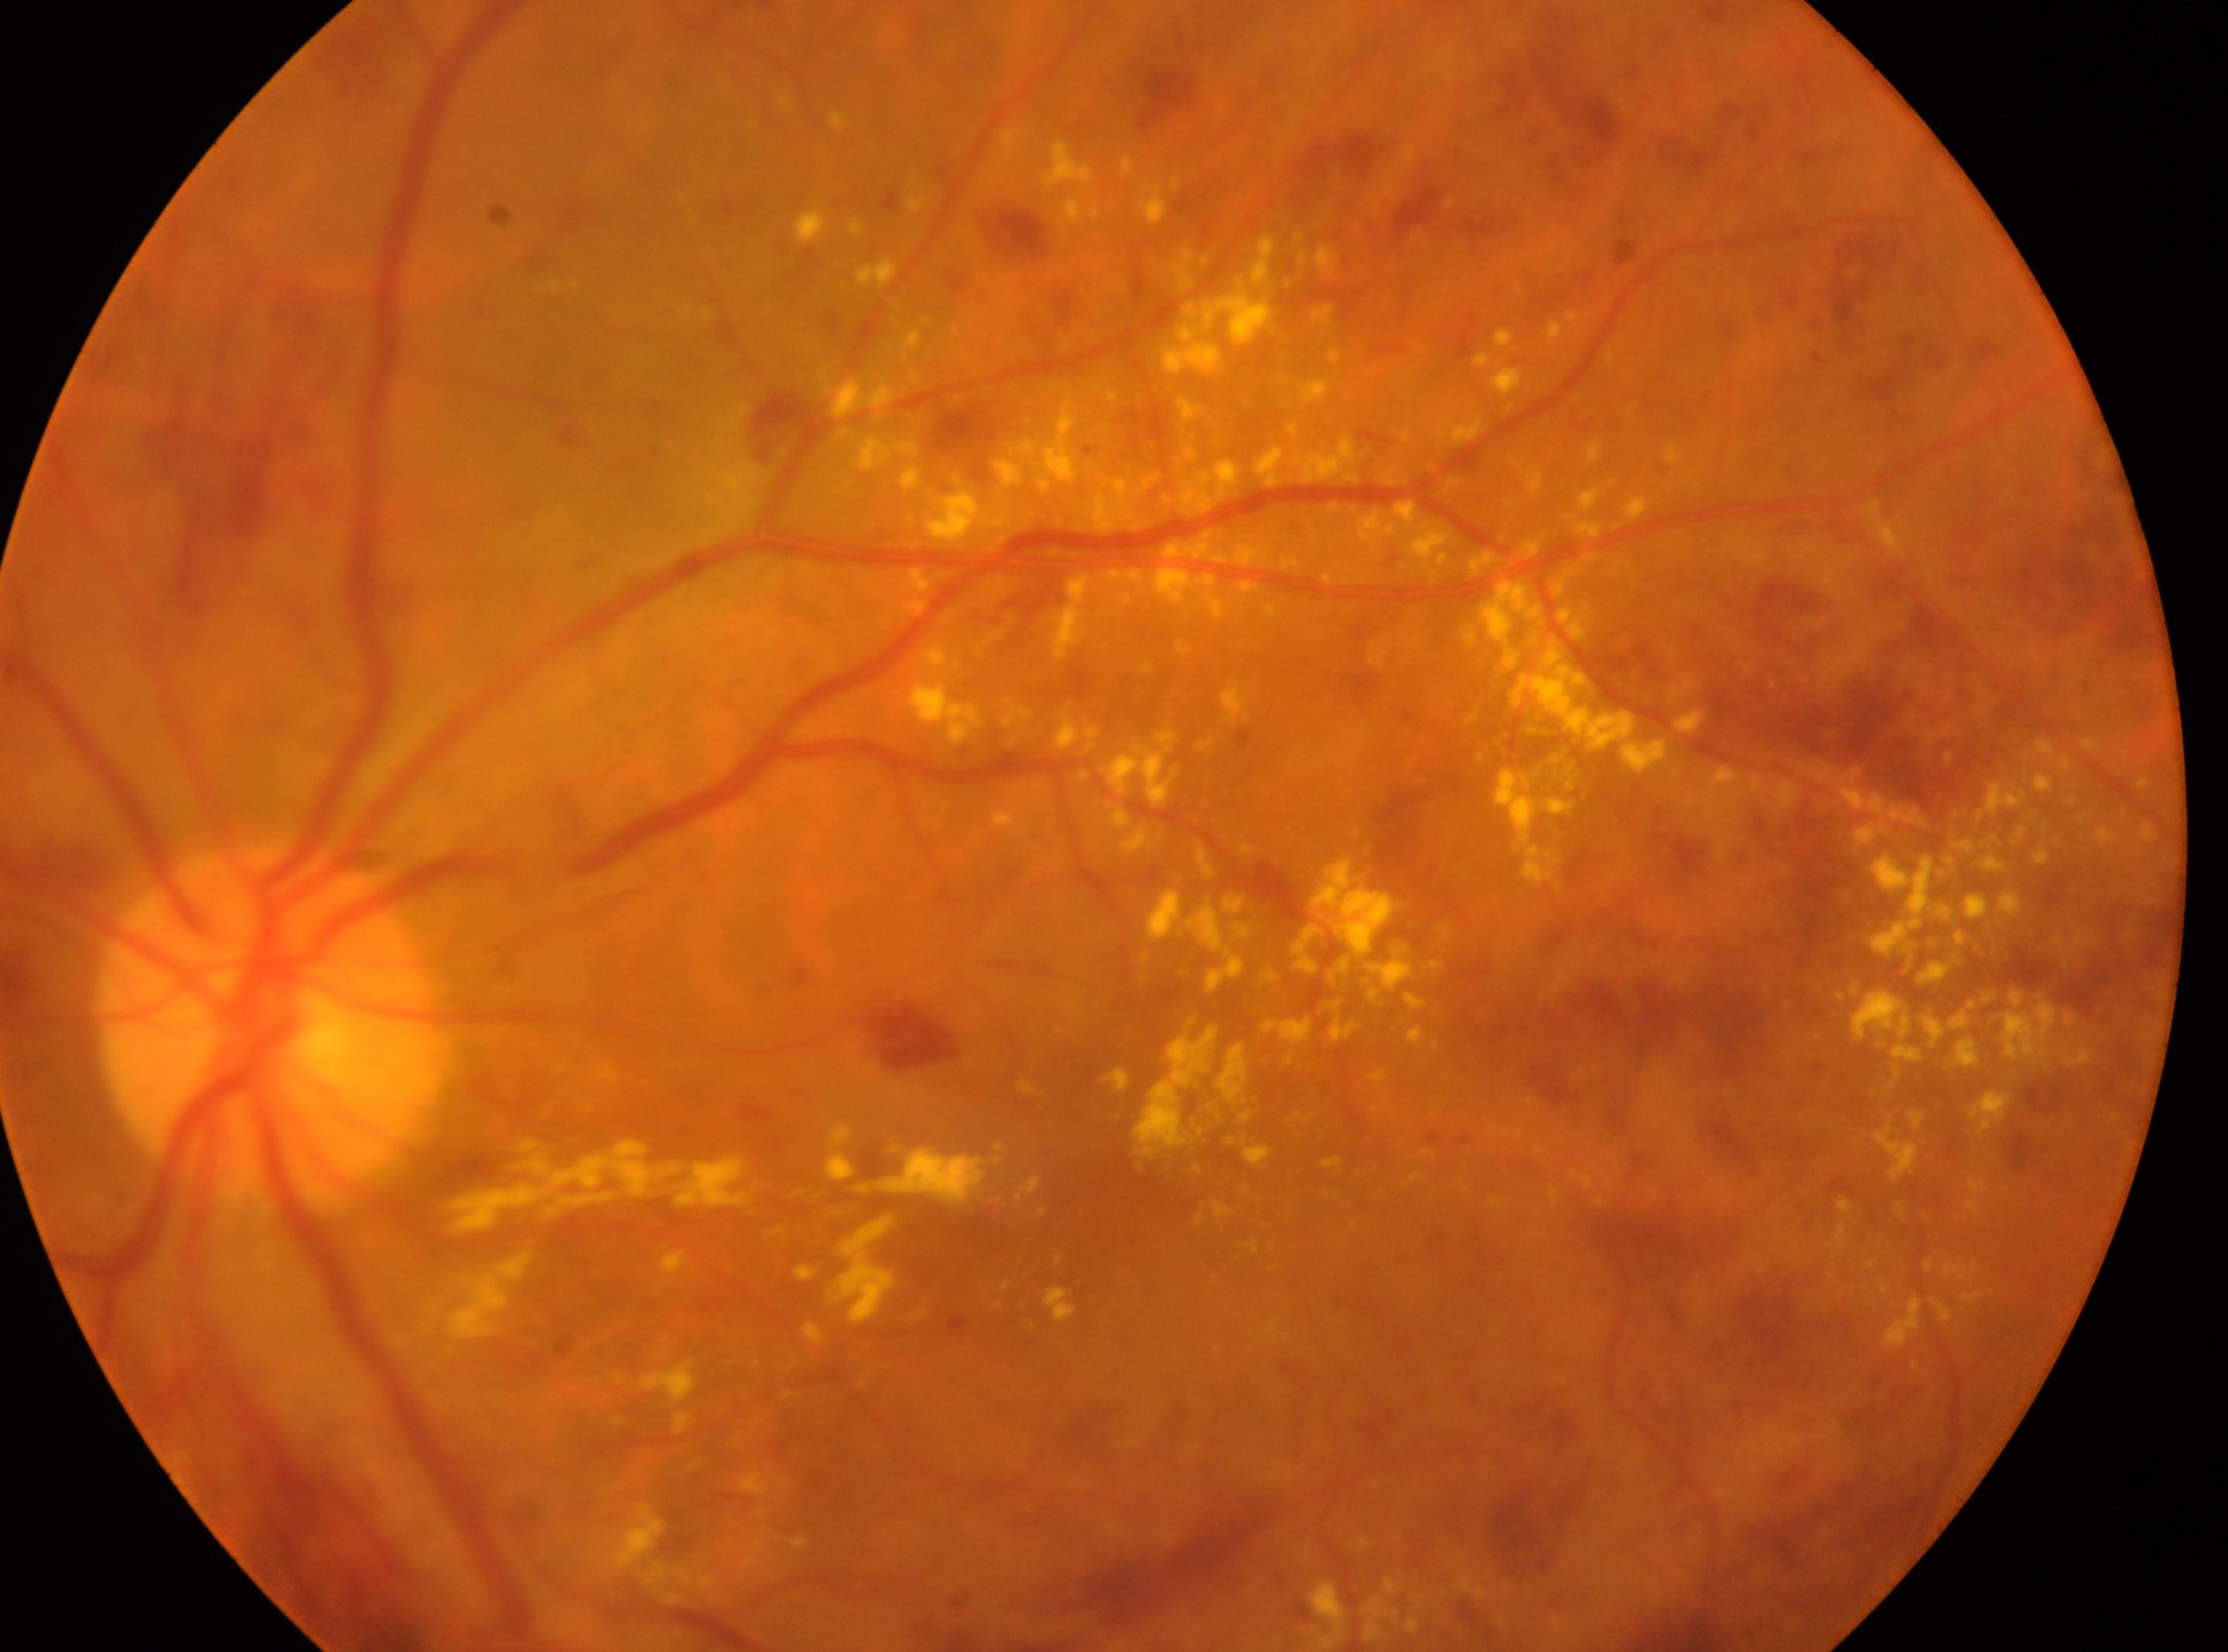

Annotations:
- DR class: non-proliferative diabetic retinopathy
- diabetic retinopathy severity: severe non-proliferative diabetic retinopathy (grade 3)
- laterality: the left eye
- fovea center: 1108, 1186
- the optic disc: 267, 1022